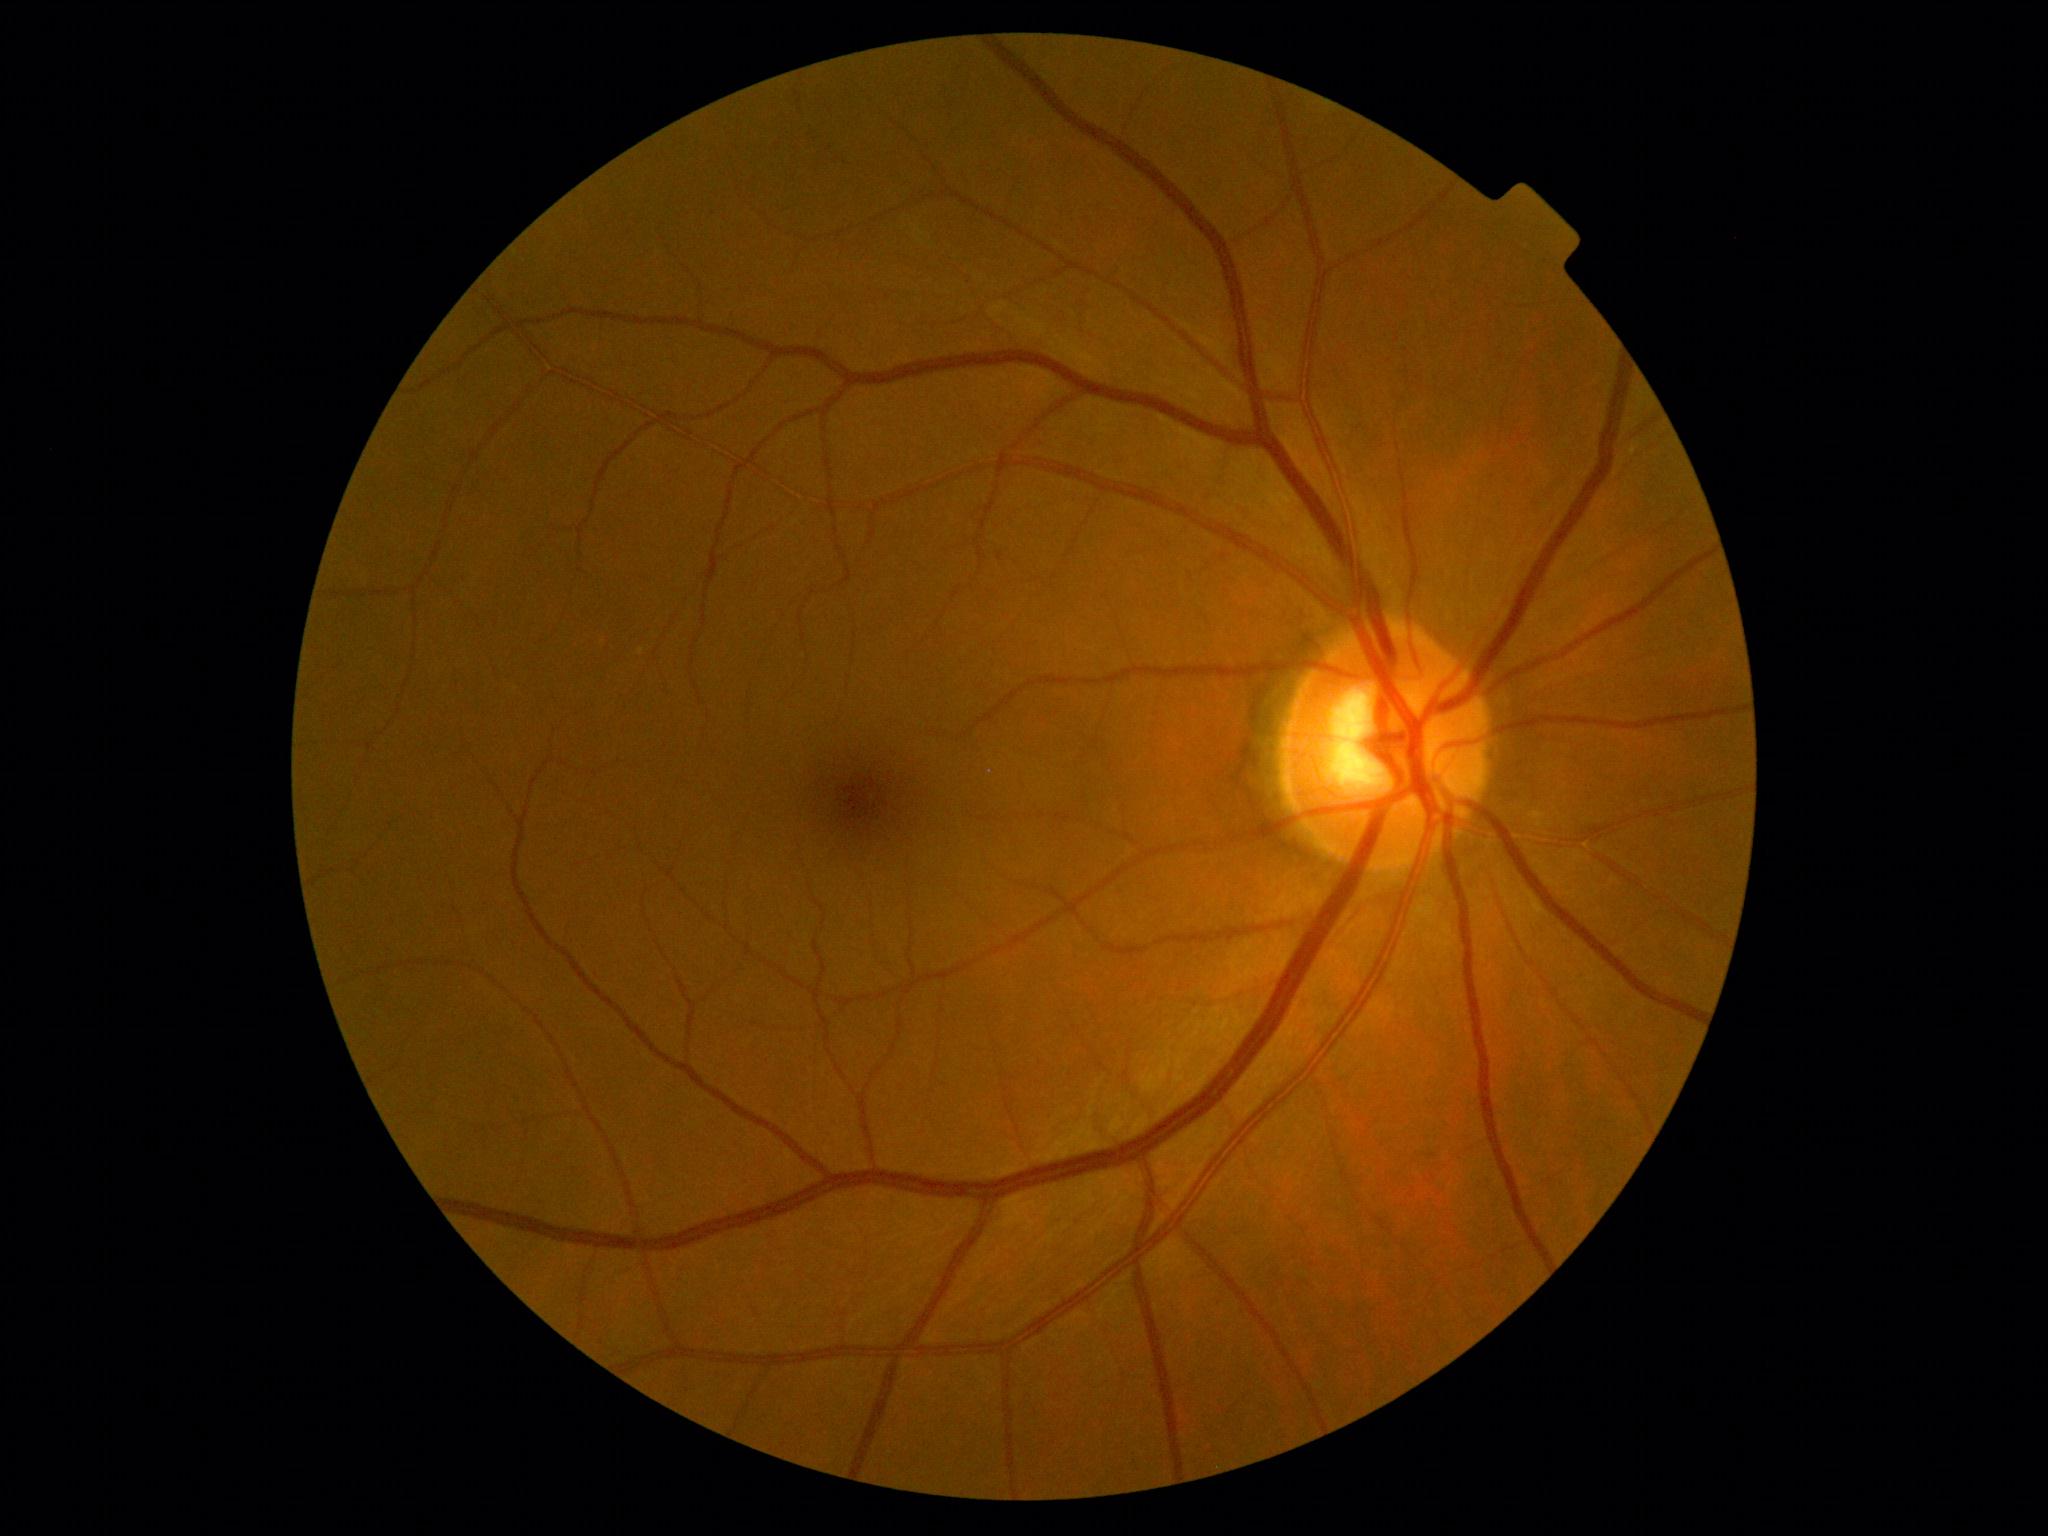

Diabetic retinopathy (DR): no apparent retinopathy (grade 0).